Wide-field contact fundus photograph of an infant:
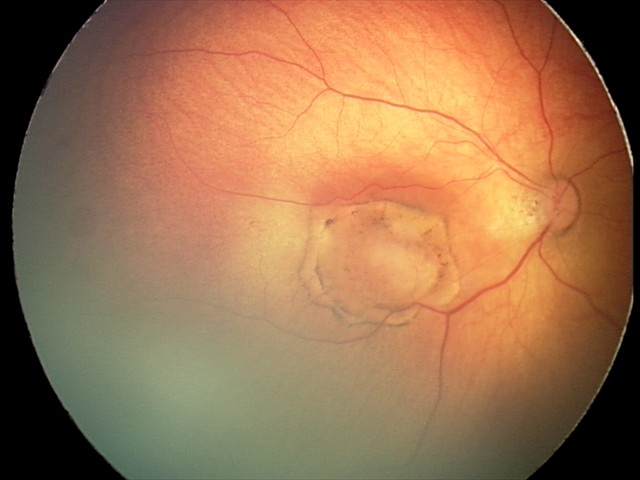
Screening series with toxoplasmosis chorioretinitis.